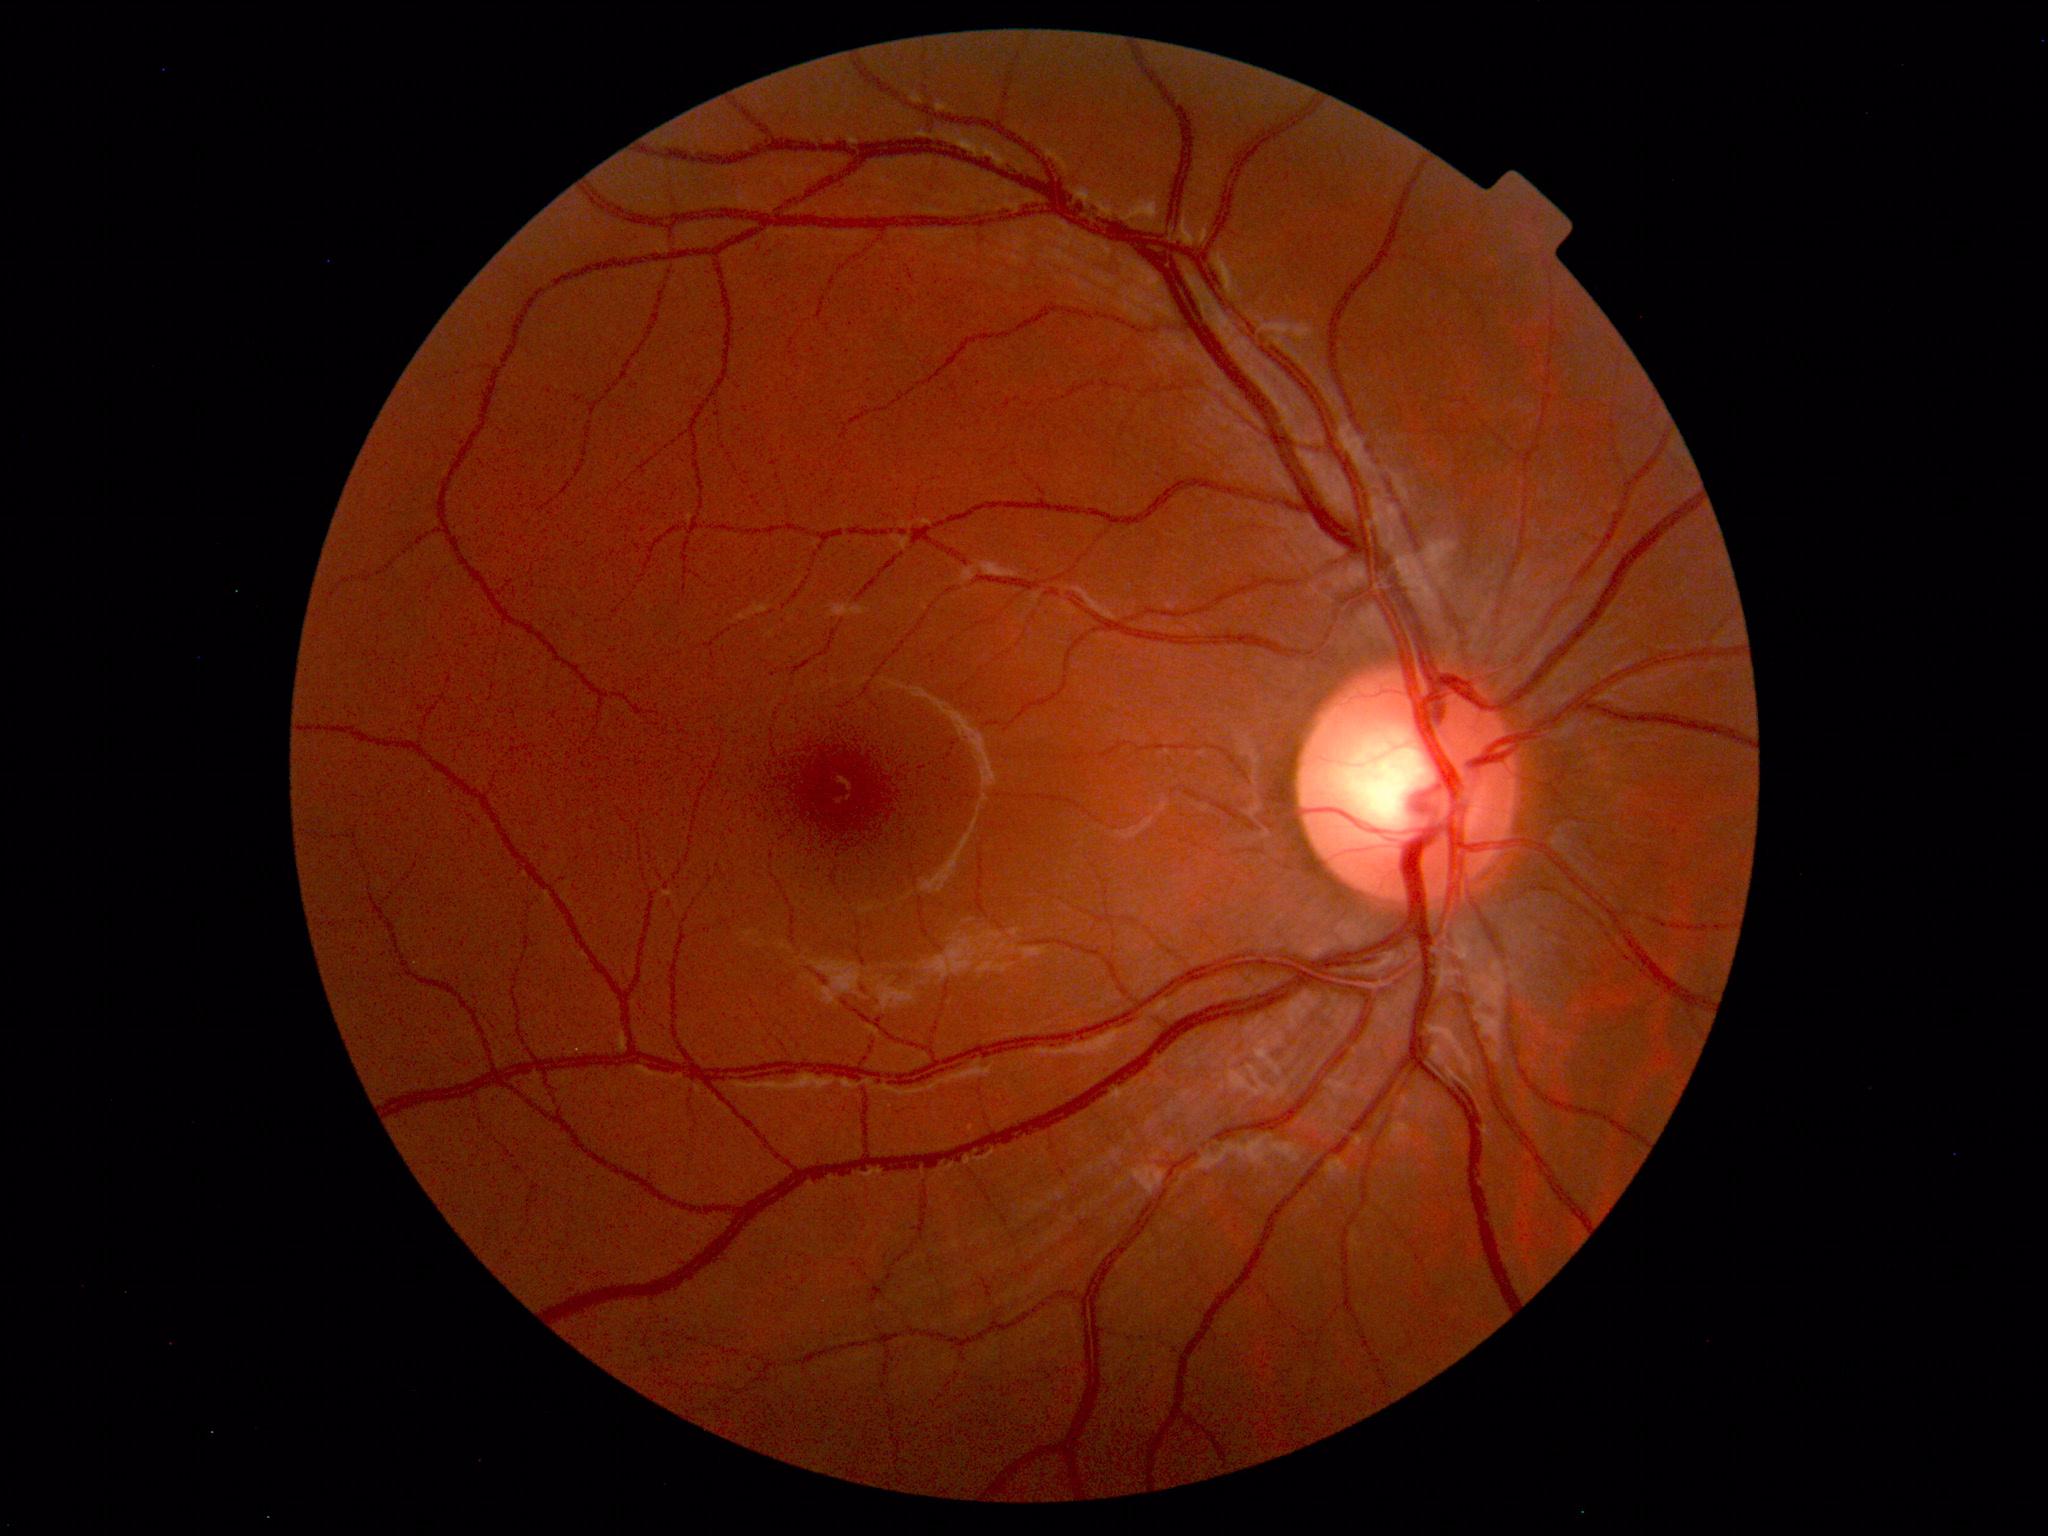

Findings: no abnormalities.